Phoenix ICON wide-field infant fundus image: 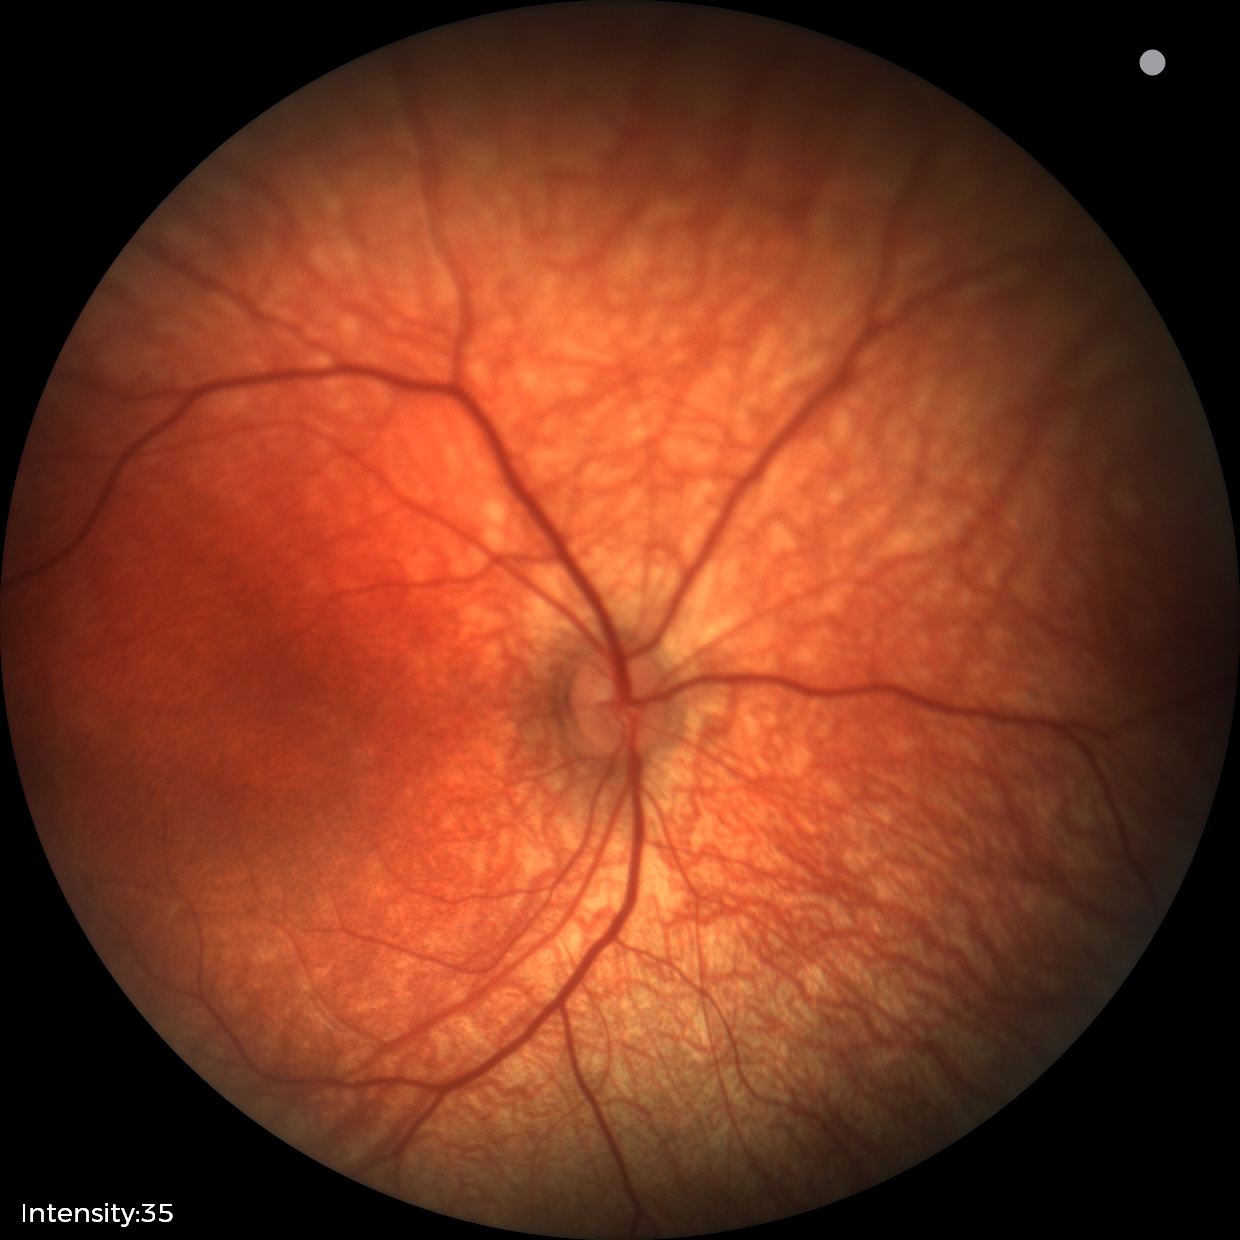
Screening: no abnormal retinal findings.